45-degree field of view; 2352x1568.
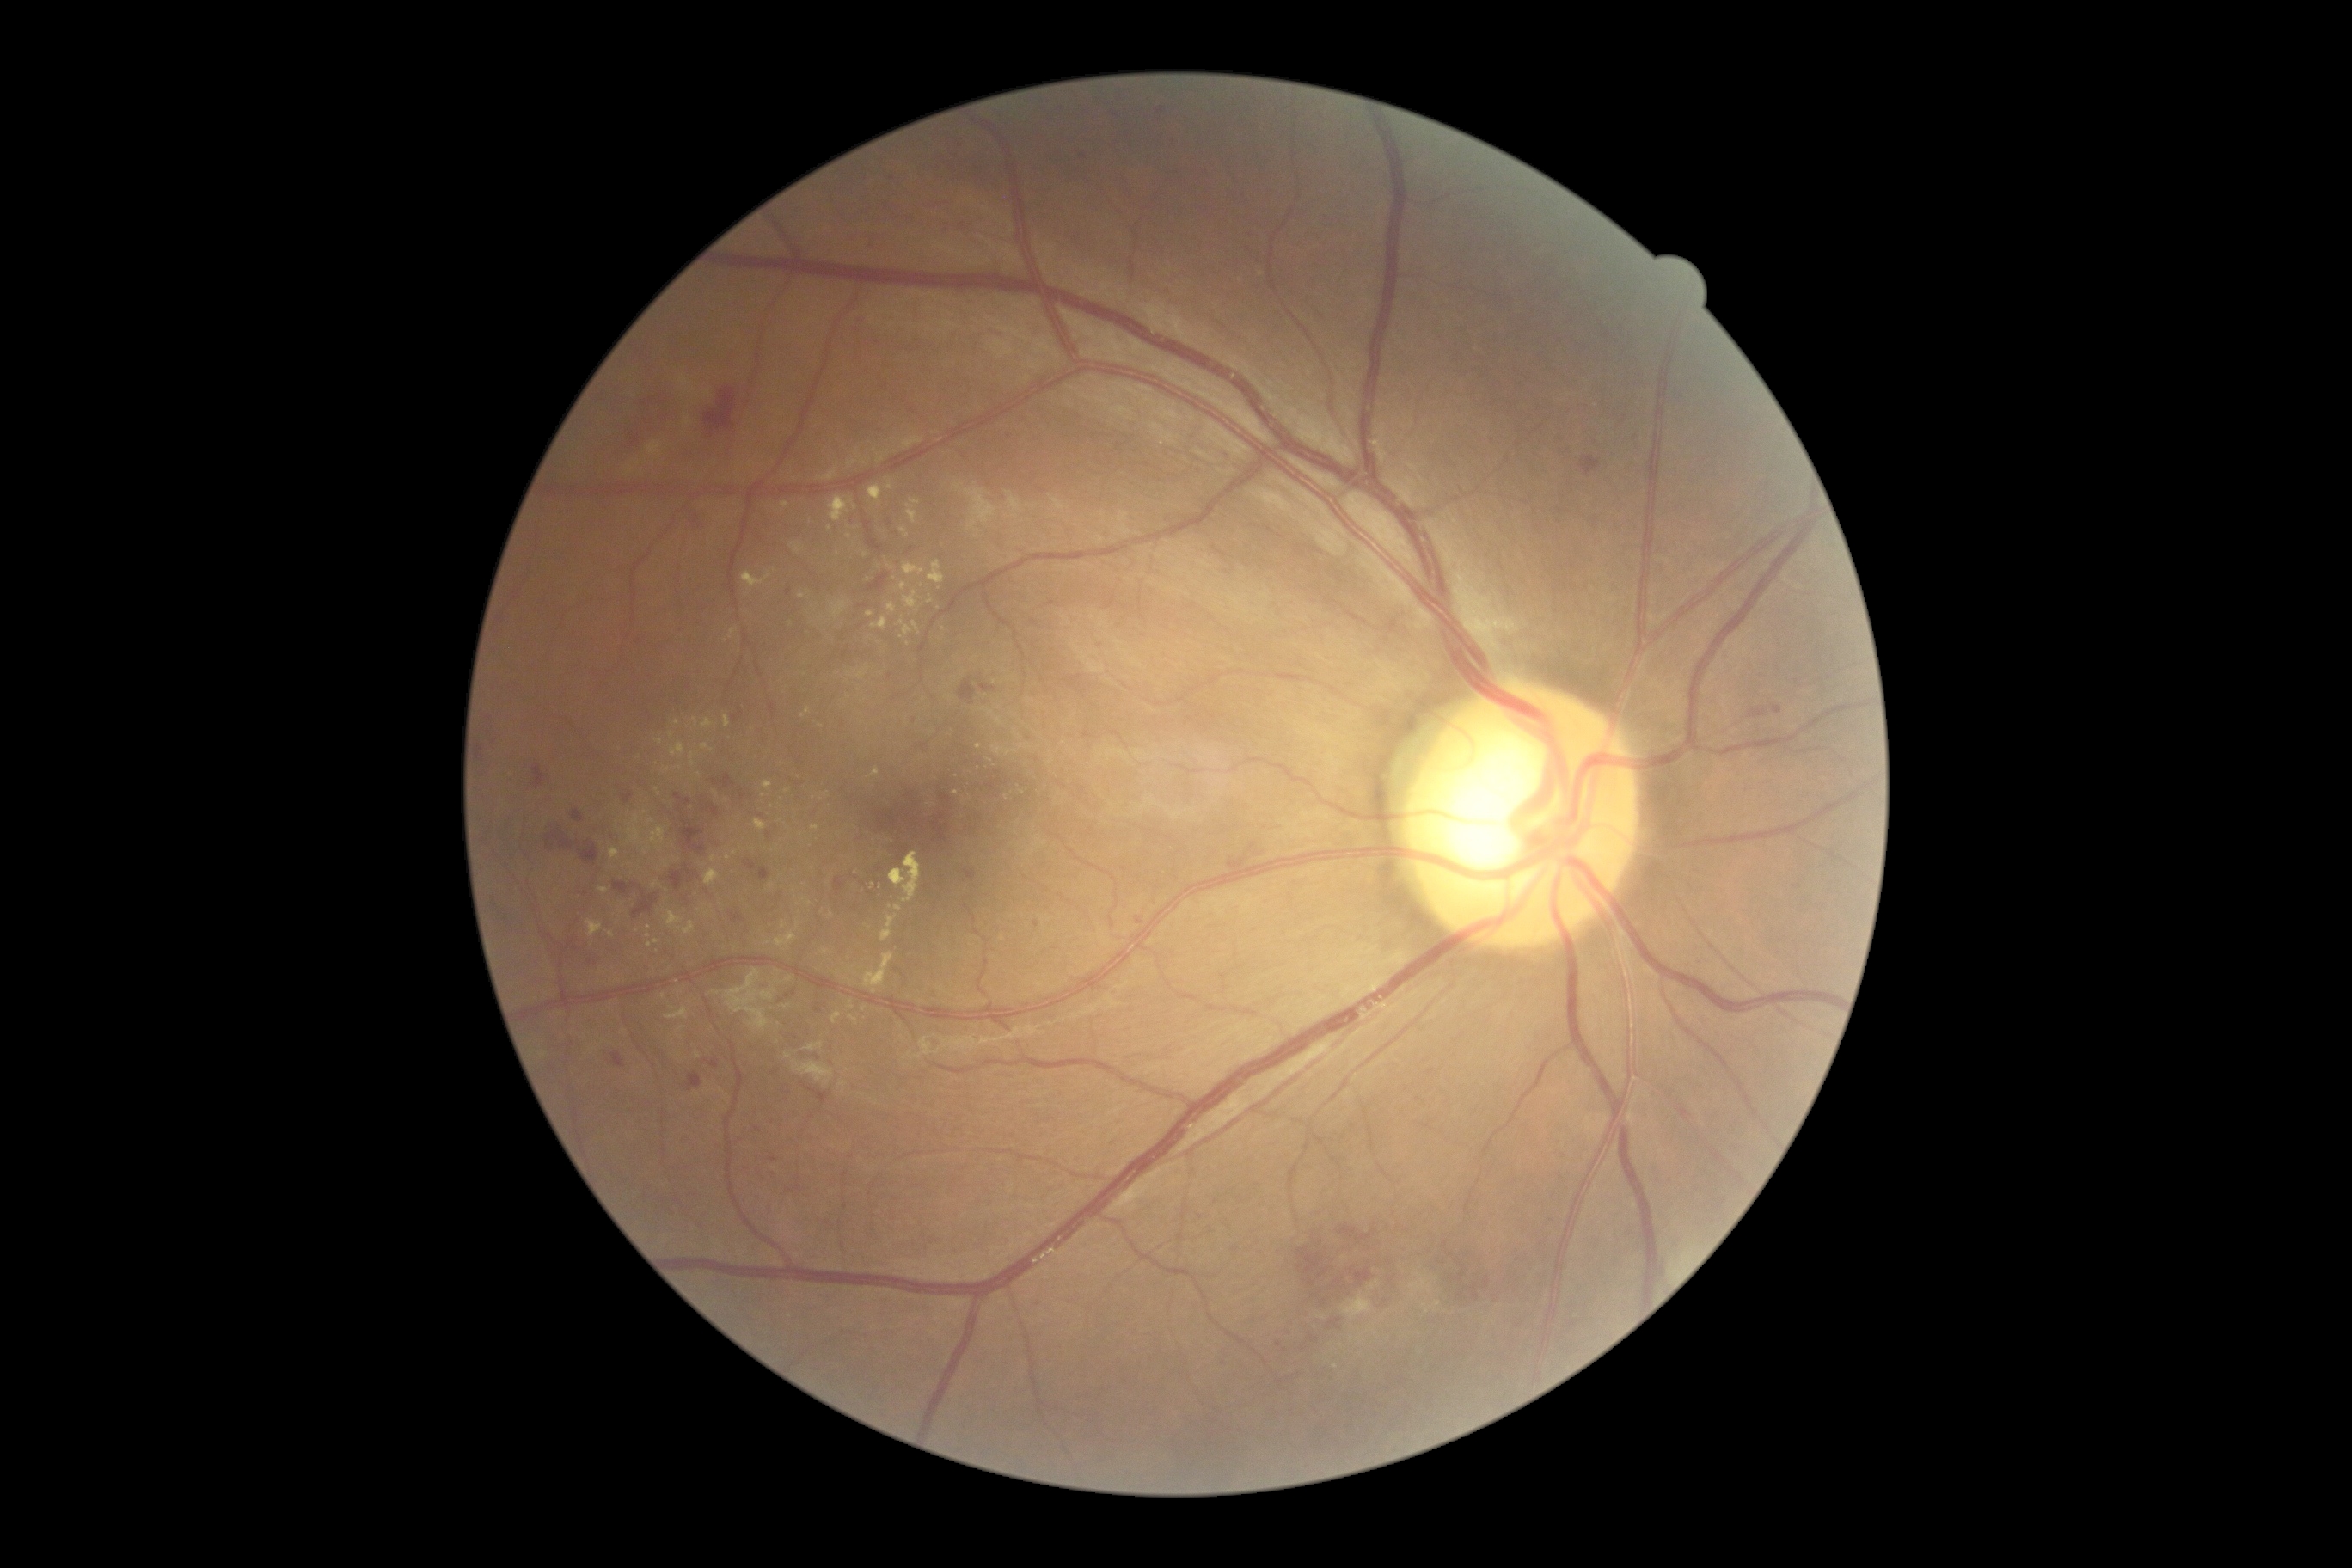

partial: true
dr_grade: 2
lesions:
  he:
    - x1=757, y1=816, x2=766, y2=821
    - x1=965, y1=871, x2=976, y2=879
    - x1=959, y1=678, x2=976, y2=706
    - x1=1338, y1=1225, x2=1378, y2=1246
    - x1=979, y1=685, x2=996, y2=694
    - x1=1455, y1=1261, x2=1469, y2=1283
    - x1=926, y1=788, x2=953, y2=847
    - x1=867, y1=573, x2=888, y2=592
    - x1=740, y1=792, x2=745, y2=802
    - x1=1457, y1=1277, x2=1491, y2=1302
    - x1=730, y1=912, x2=747, y2=924
    - x1=625, y1=388, x2=675, y2=450
    - x1=898, y1=847, x2=910, y2=862
    - x1=689, y1=508, x2=706, y2=524
    - x1=623, y1=793, x2=634, y2=804
  he_small_centers:
    - [1450, 1256]
    - [768, 835]
  ex:
    - x1=850, y1=1015, x2=859, y2=1026
    - x1=666, y1=1008, x2=689, y2=1020
    - x1=756, y1=819, x2=768, y2=831
    - x1=938, y1=988, x2=946, y2=993
    - x1=670, y1=744, x2=685, y2=757
    - x1=881, y1=916, x2=898, y2=943
    - x1=654, y1=738, x2=663, y2=745
    - x1=647, y1=940, x2=659, y2=948
    - x1=864, y1=953, x2=895, y2=995
  ex_small_centers:
    - [784, 925]
    - [890, 908]
    - [663, 997]
    - [695, 722]
    - [891, 567]
    - [764, 797]
    - [866, 555]
    - [698, 1056]